Retinal fundus photograph · 240x240.
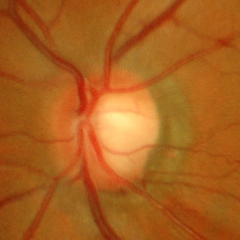

Q: Does this eye have glaucoma?
A: Early glaucoma.